Fundus photo. Acquired with a NIDEK AFC-230. 45° field of view — 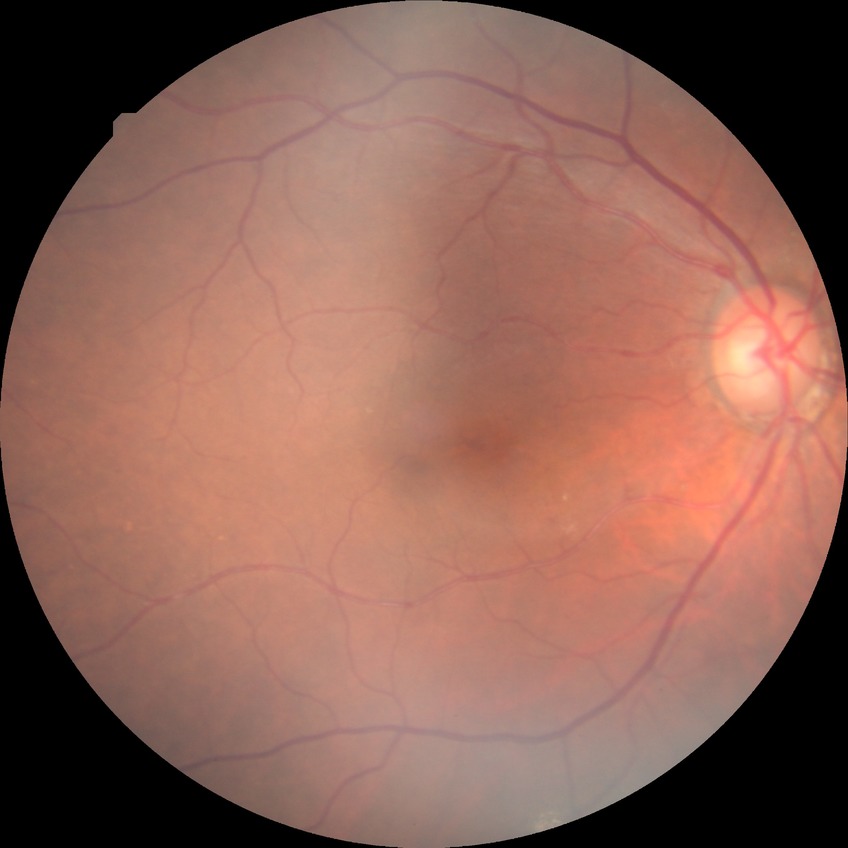 Diabetic retinopathy (DR) is NDR (no diabetic retinopathy).